Posterior pole color fundus photograph. DR severity per modified Davis staging:
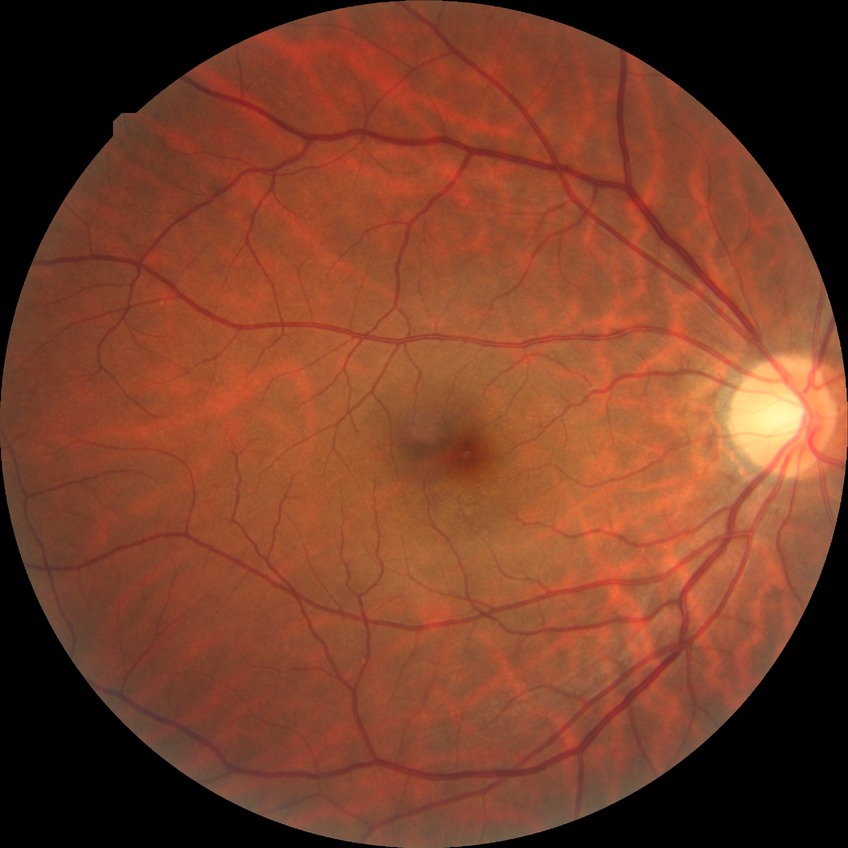

DR grade: NDR.